Color fundus photograph — 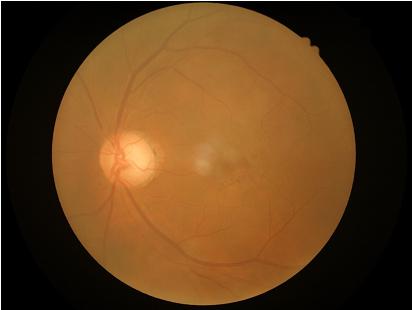 illumination: good
contrast: poor
clarity: blurry
overall_quality: low